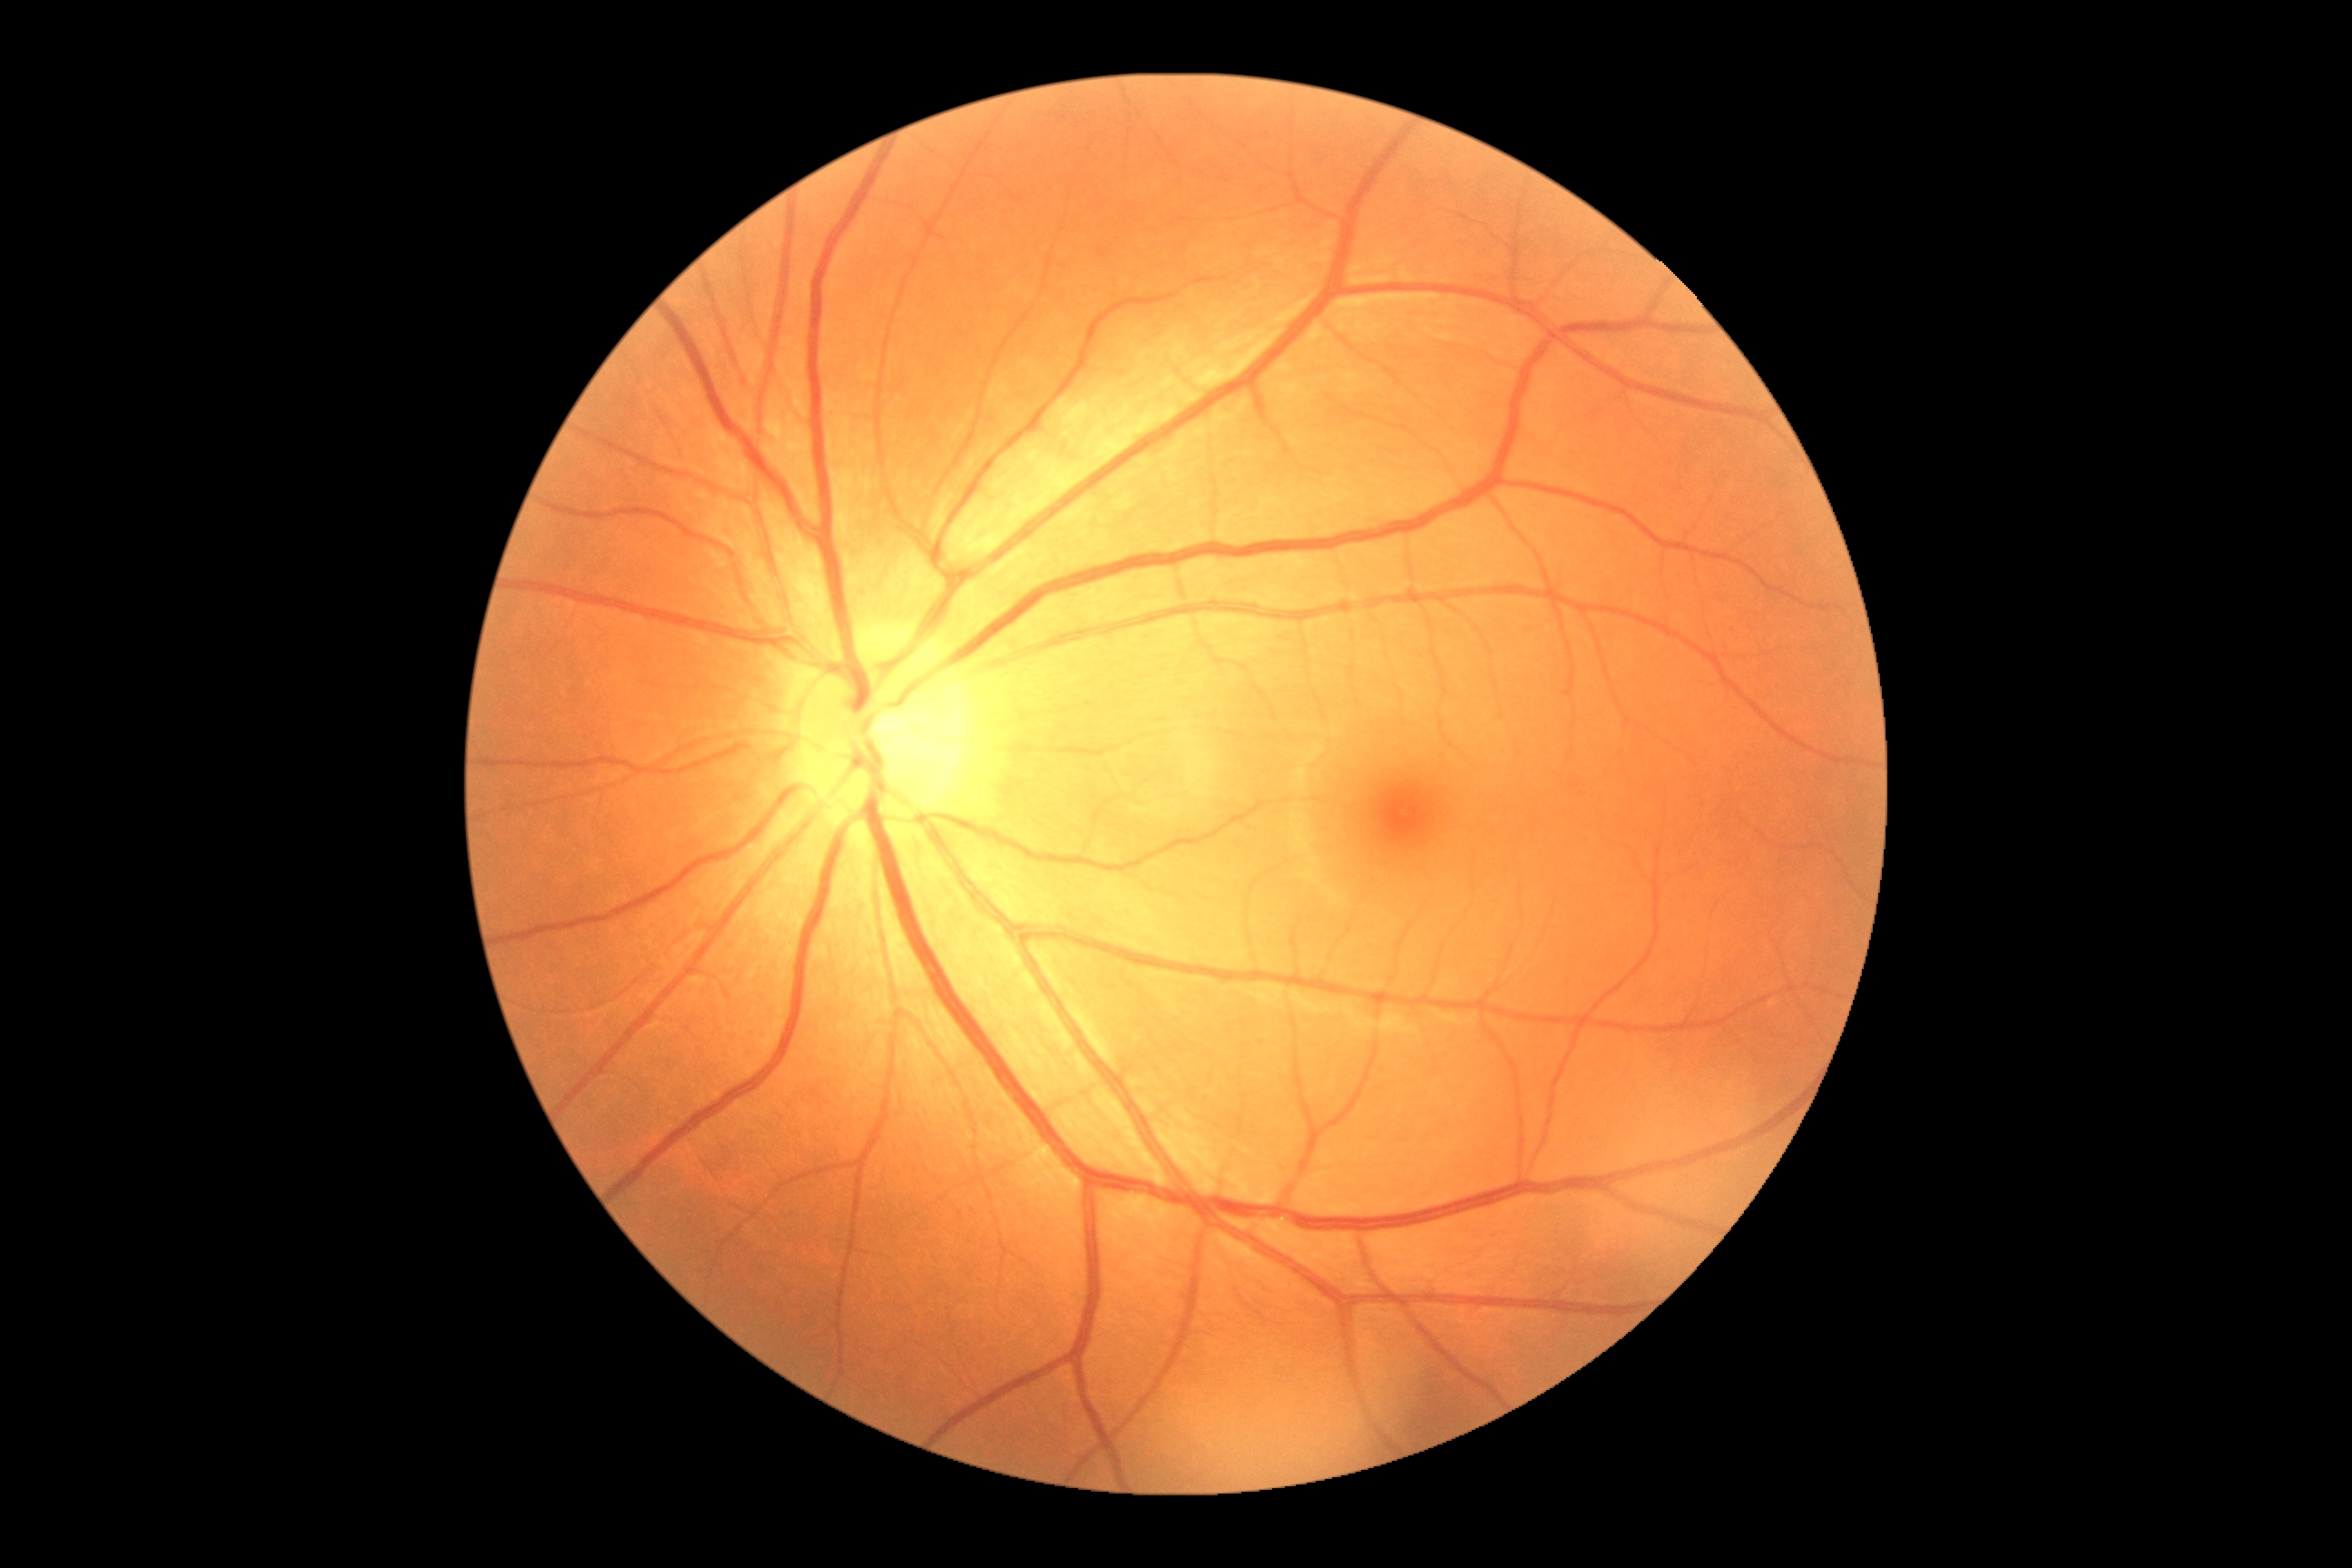

Findings:
* DR impression — no apparent DR
* DR — 0